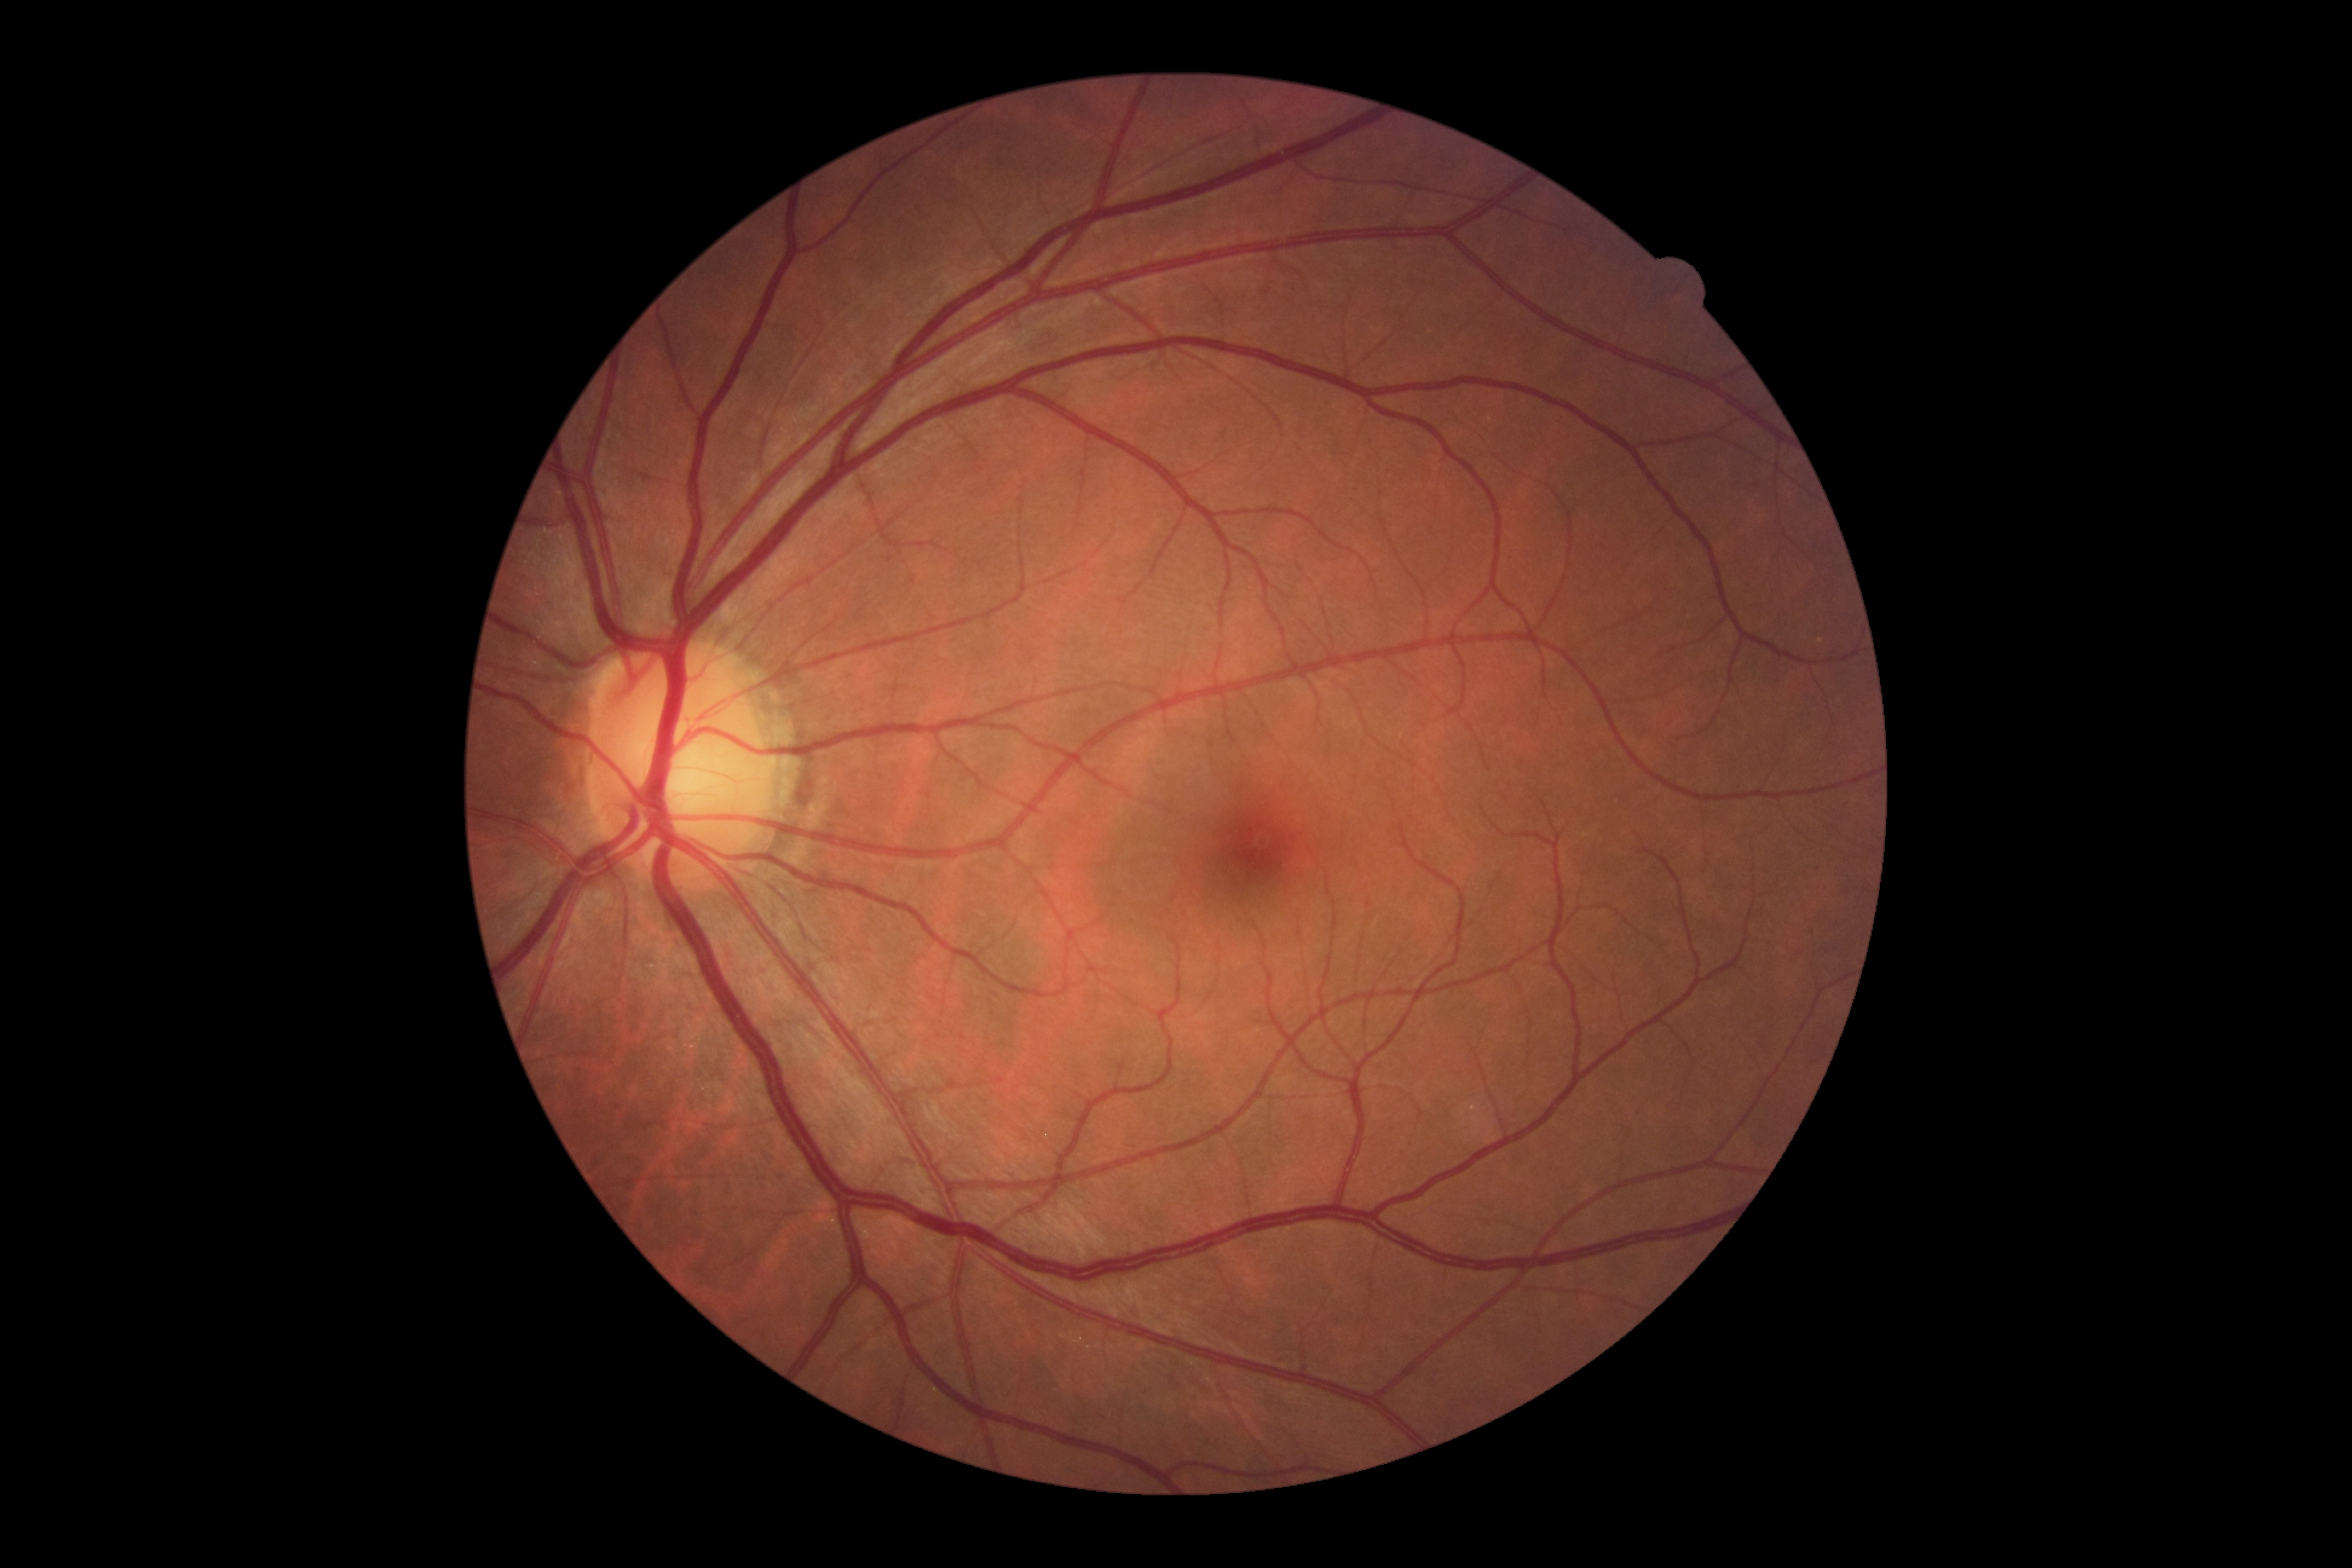

DR is no apparent retinopathy (grade 0).